Posterior pole color fundus photograph. No pharmacologic dilation.
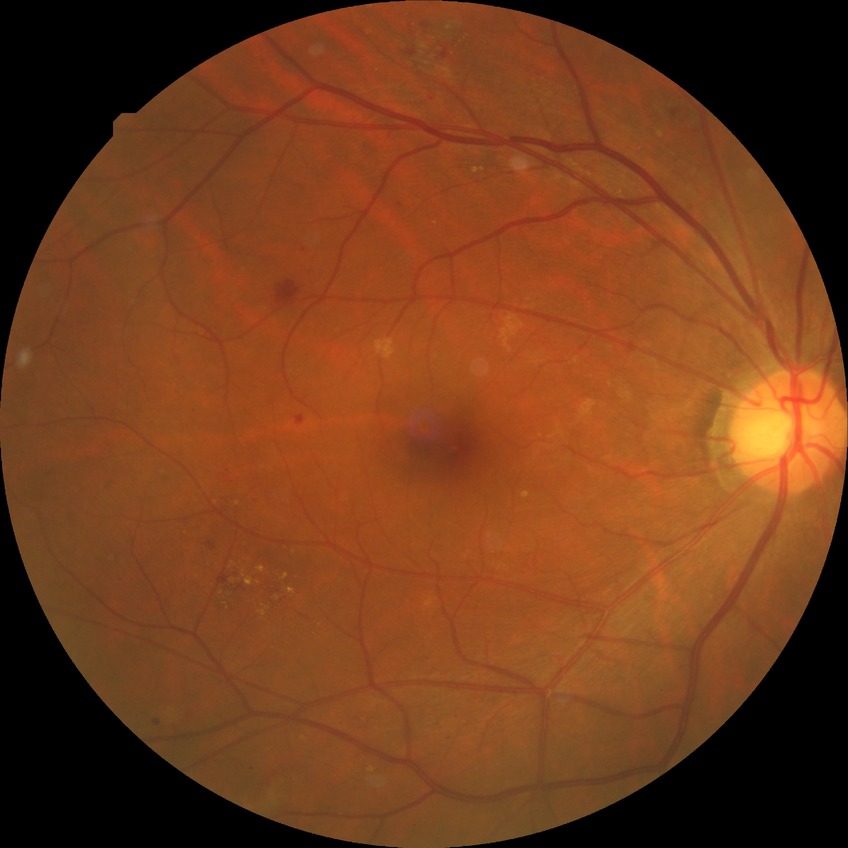 Disease class: non-proliferative diabetic retinopathy.
DR stage is PPDR.